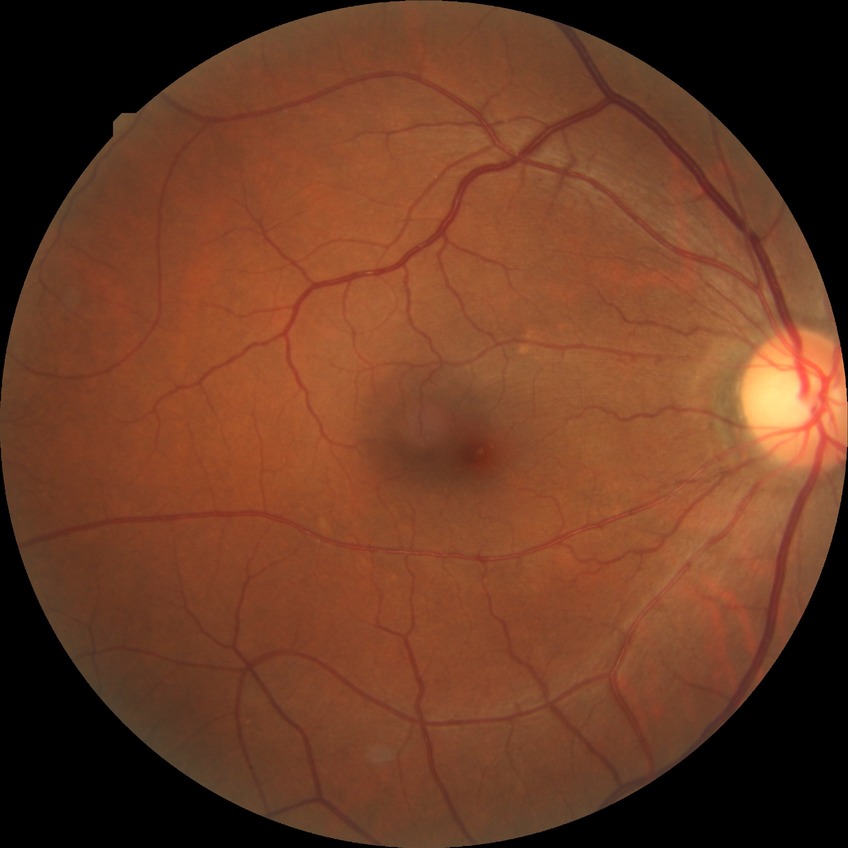

Diabetic retinopathy (DR): no diabetic retinopathy (NDR).